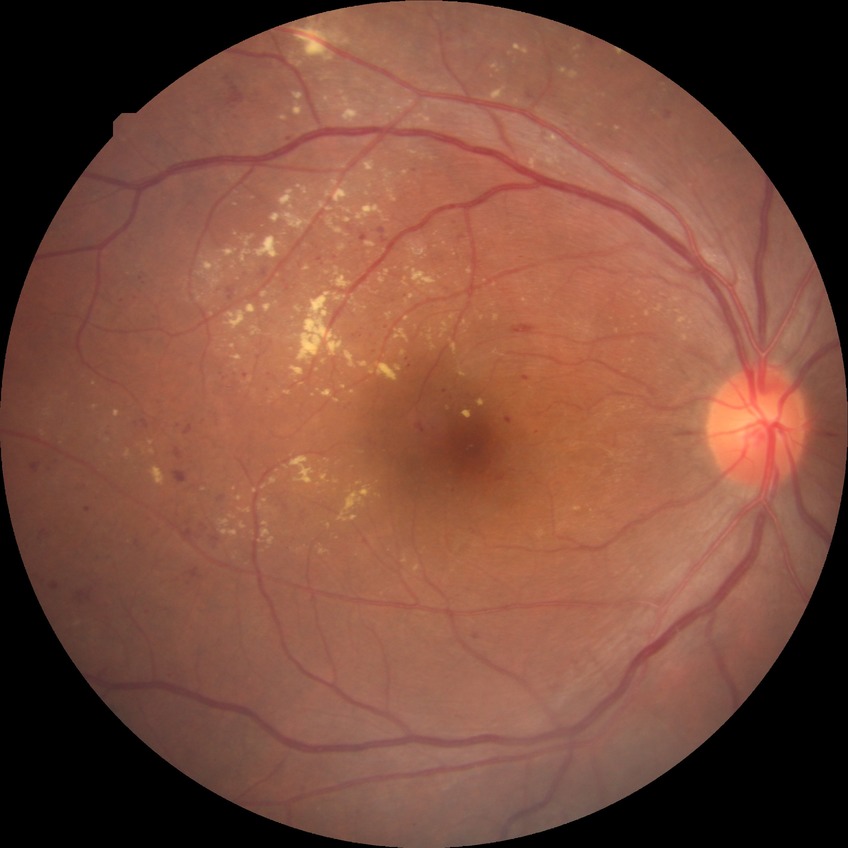 davis_grade: proliferative diabetic retinopathy